45-degree field of view; modified Davis grading; color fundus image.
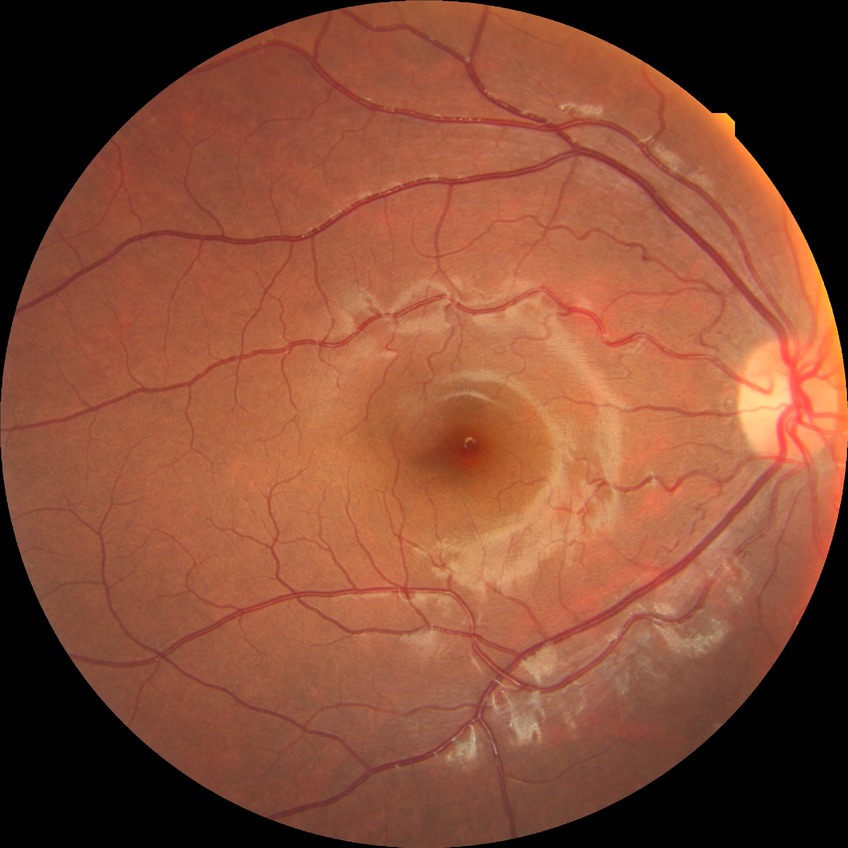 retinopathy grade@no diabetic retinopathy.